Color fundus photograph; image size 1659x2212.
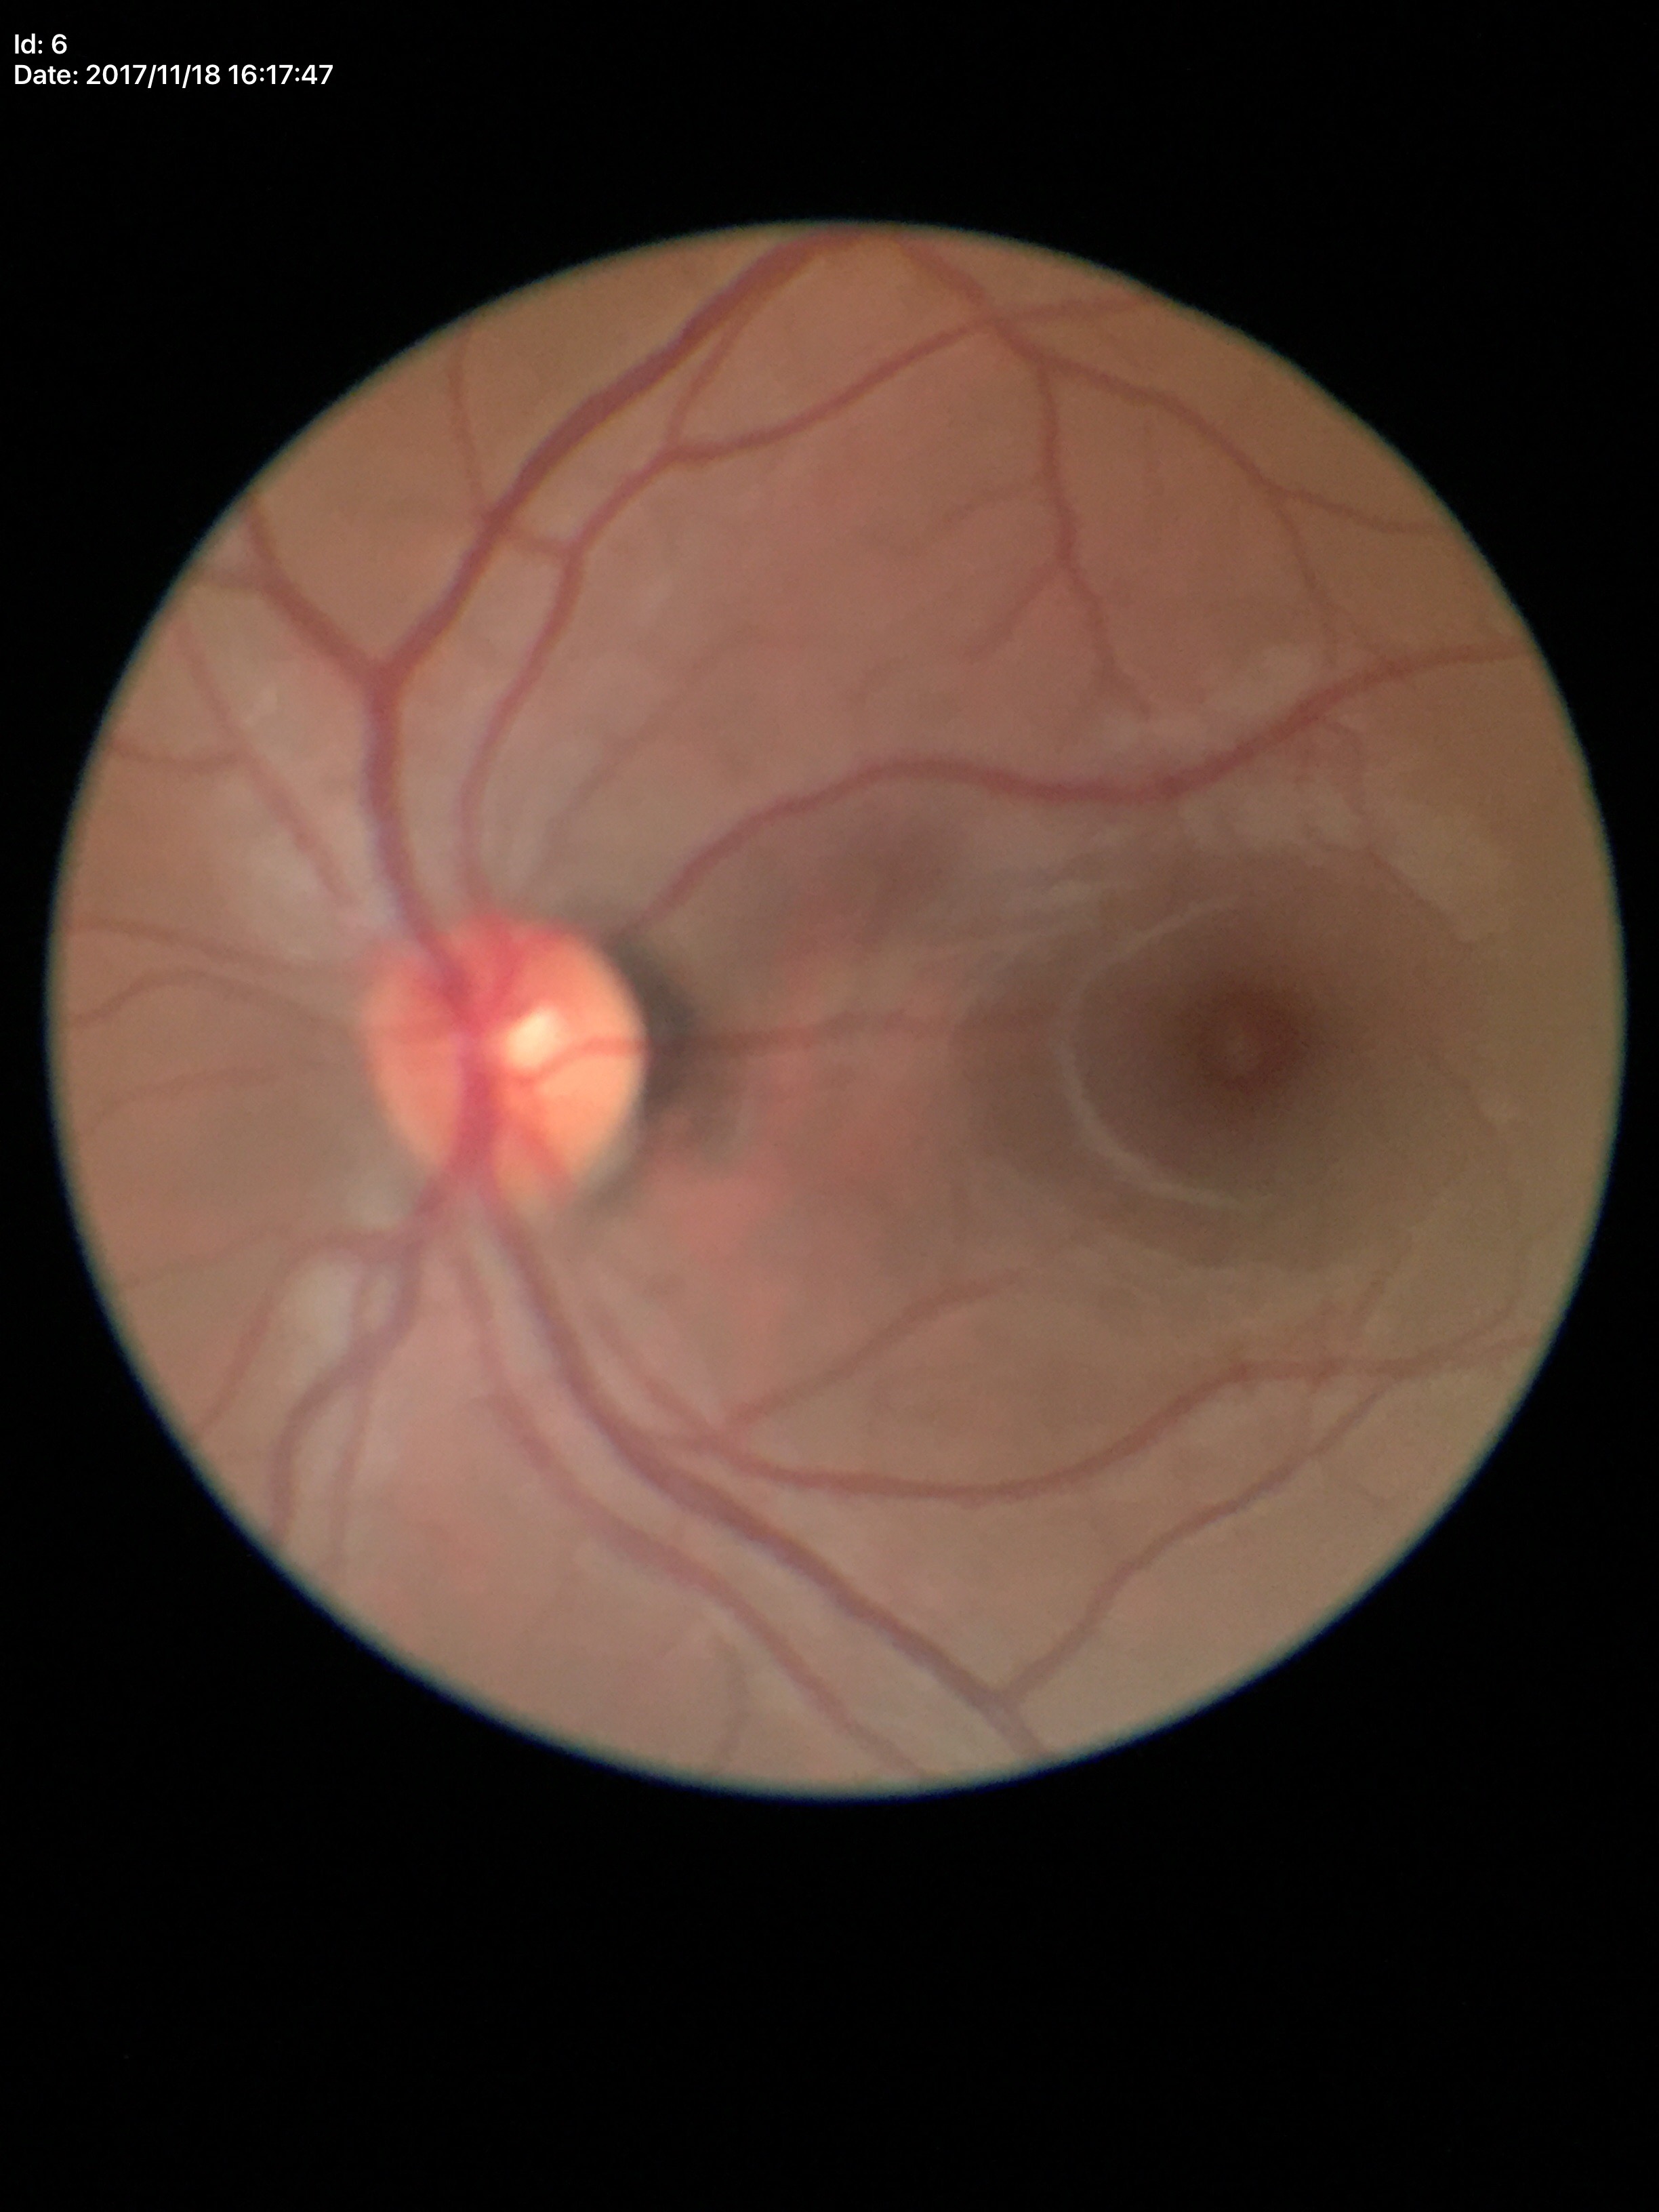
Vertical cup-to-disc ratio of 0.47. No signs of glaucoma (5/5 ophthalmologists in agreement). Area cup-disc ratio of 0.23.